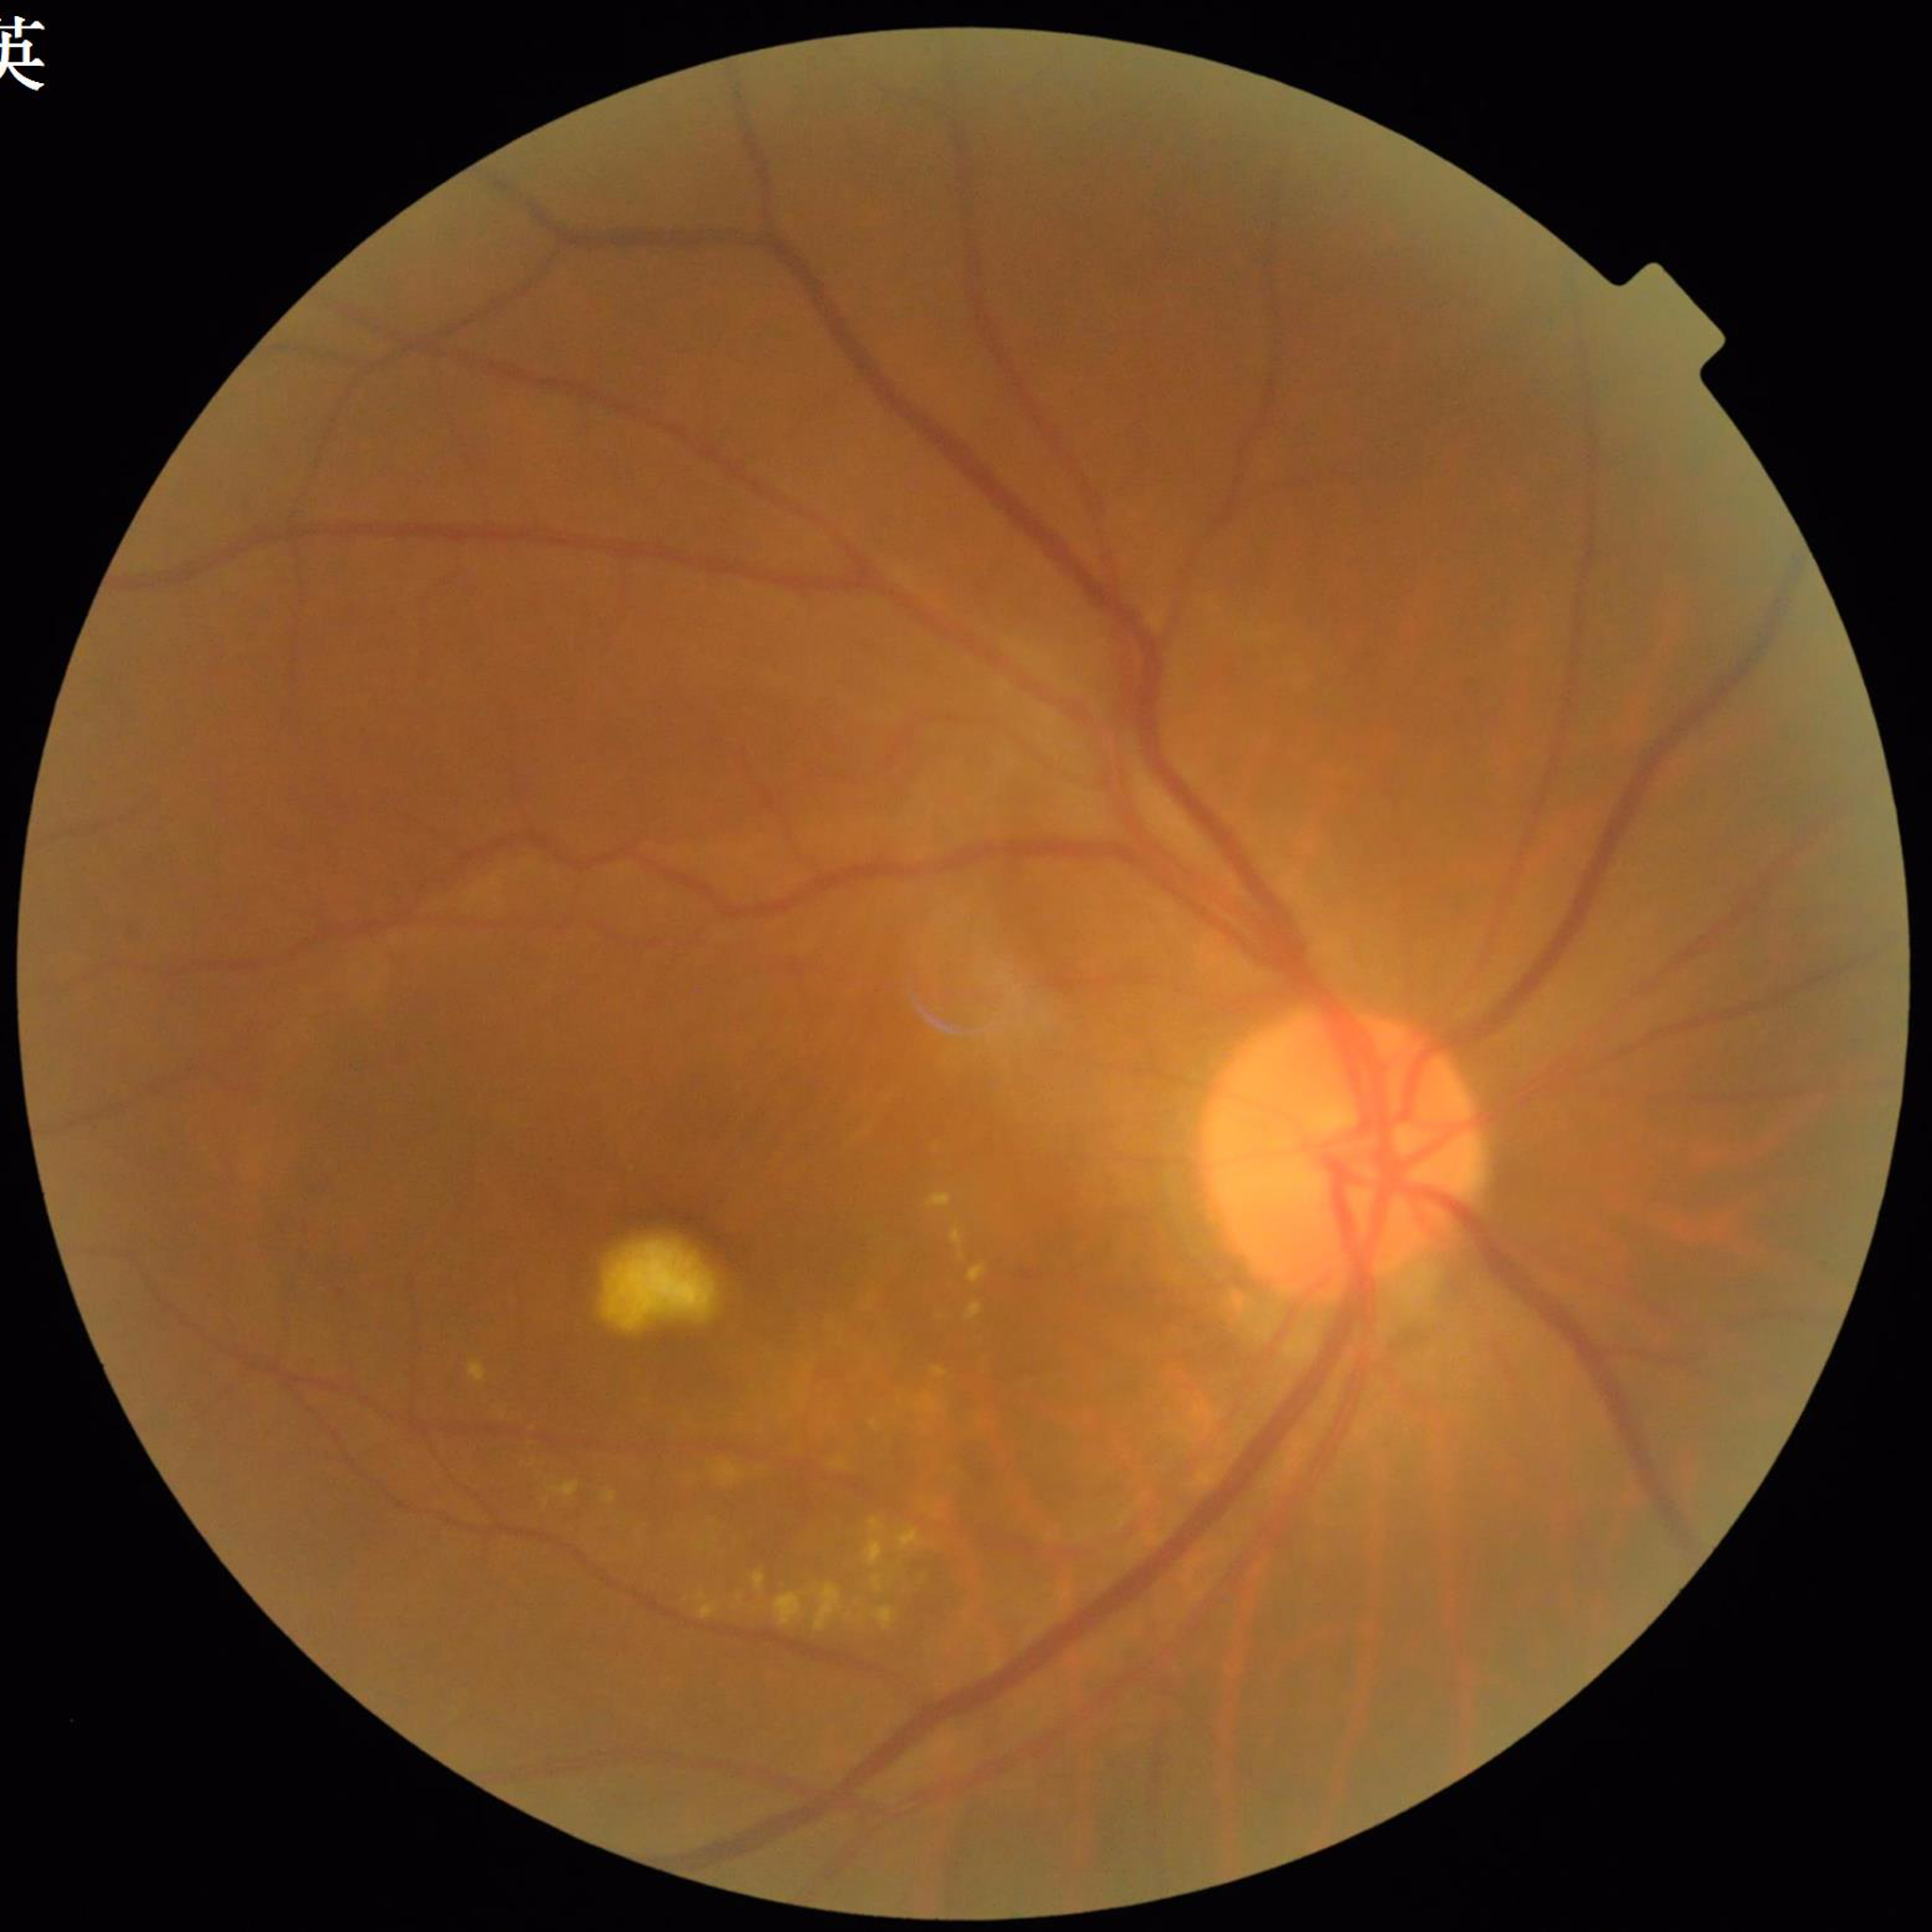
This fundus photograph is from a patient diagnosed with age-related macular degeneration (AMD).